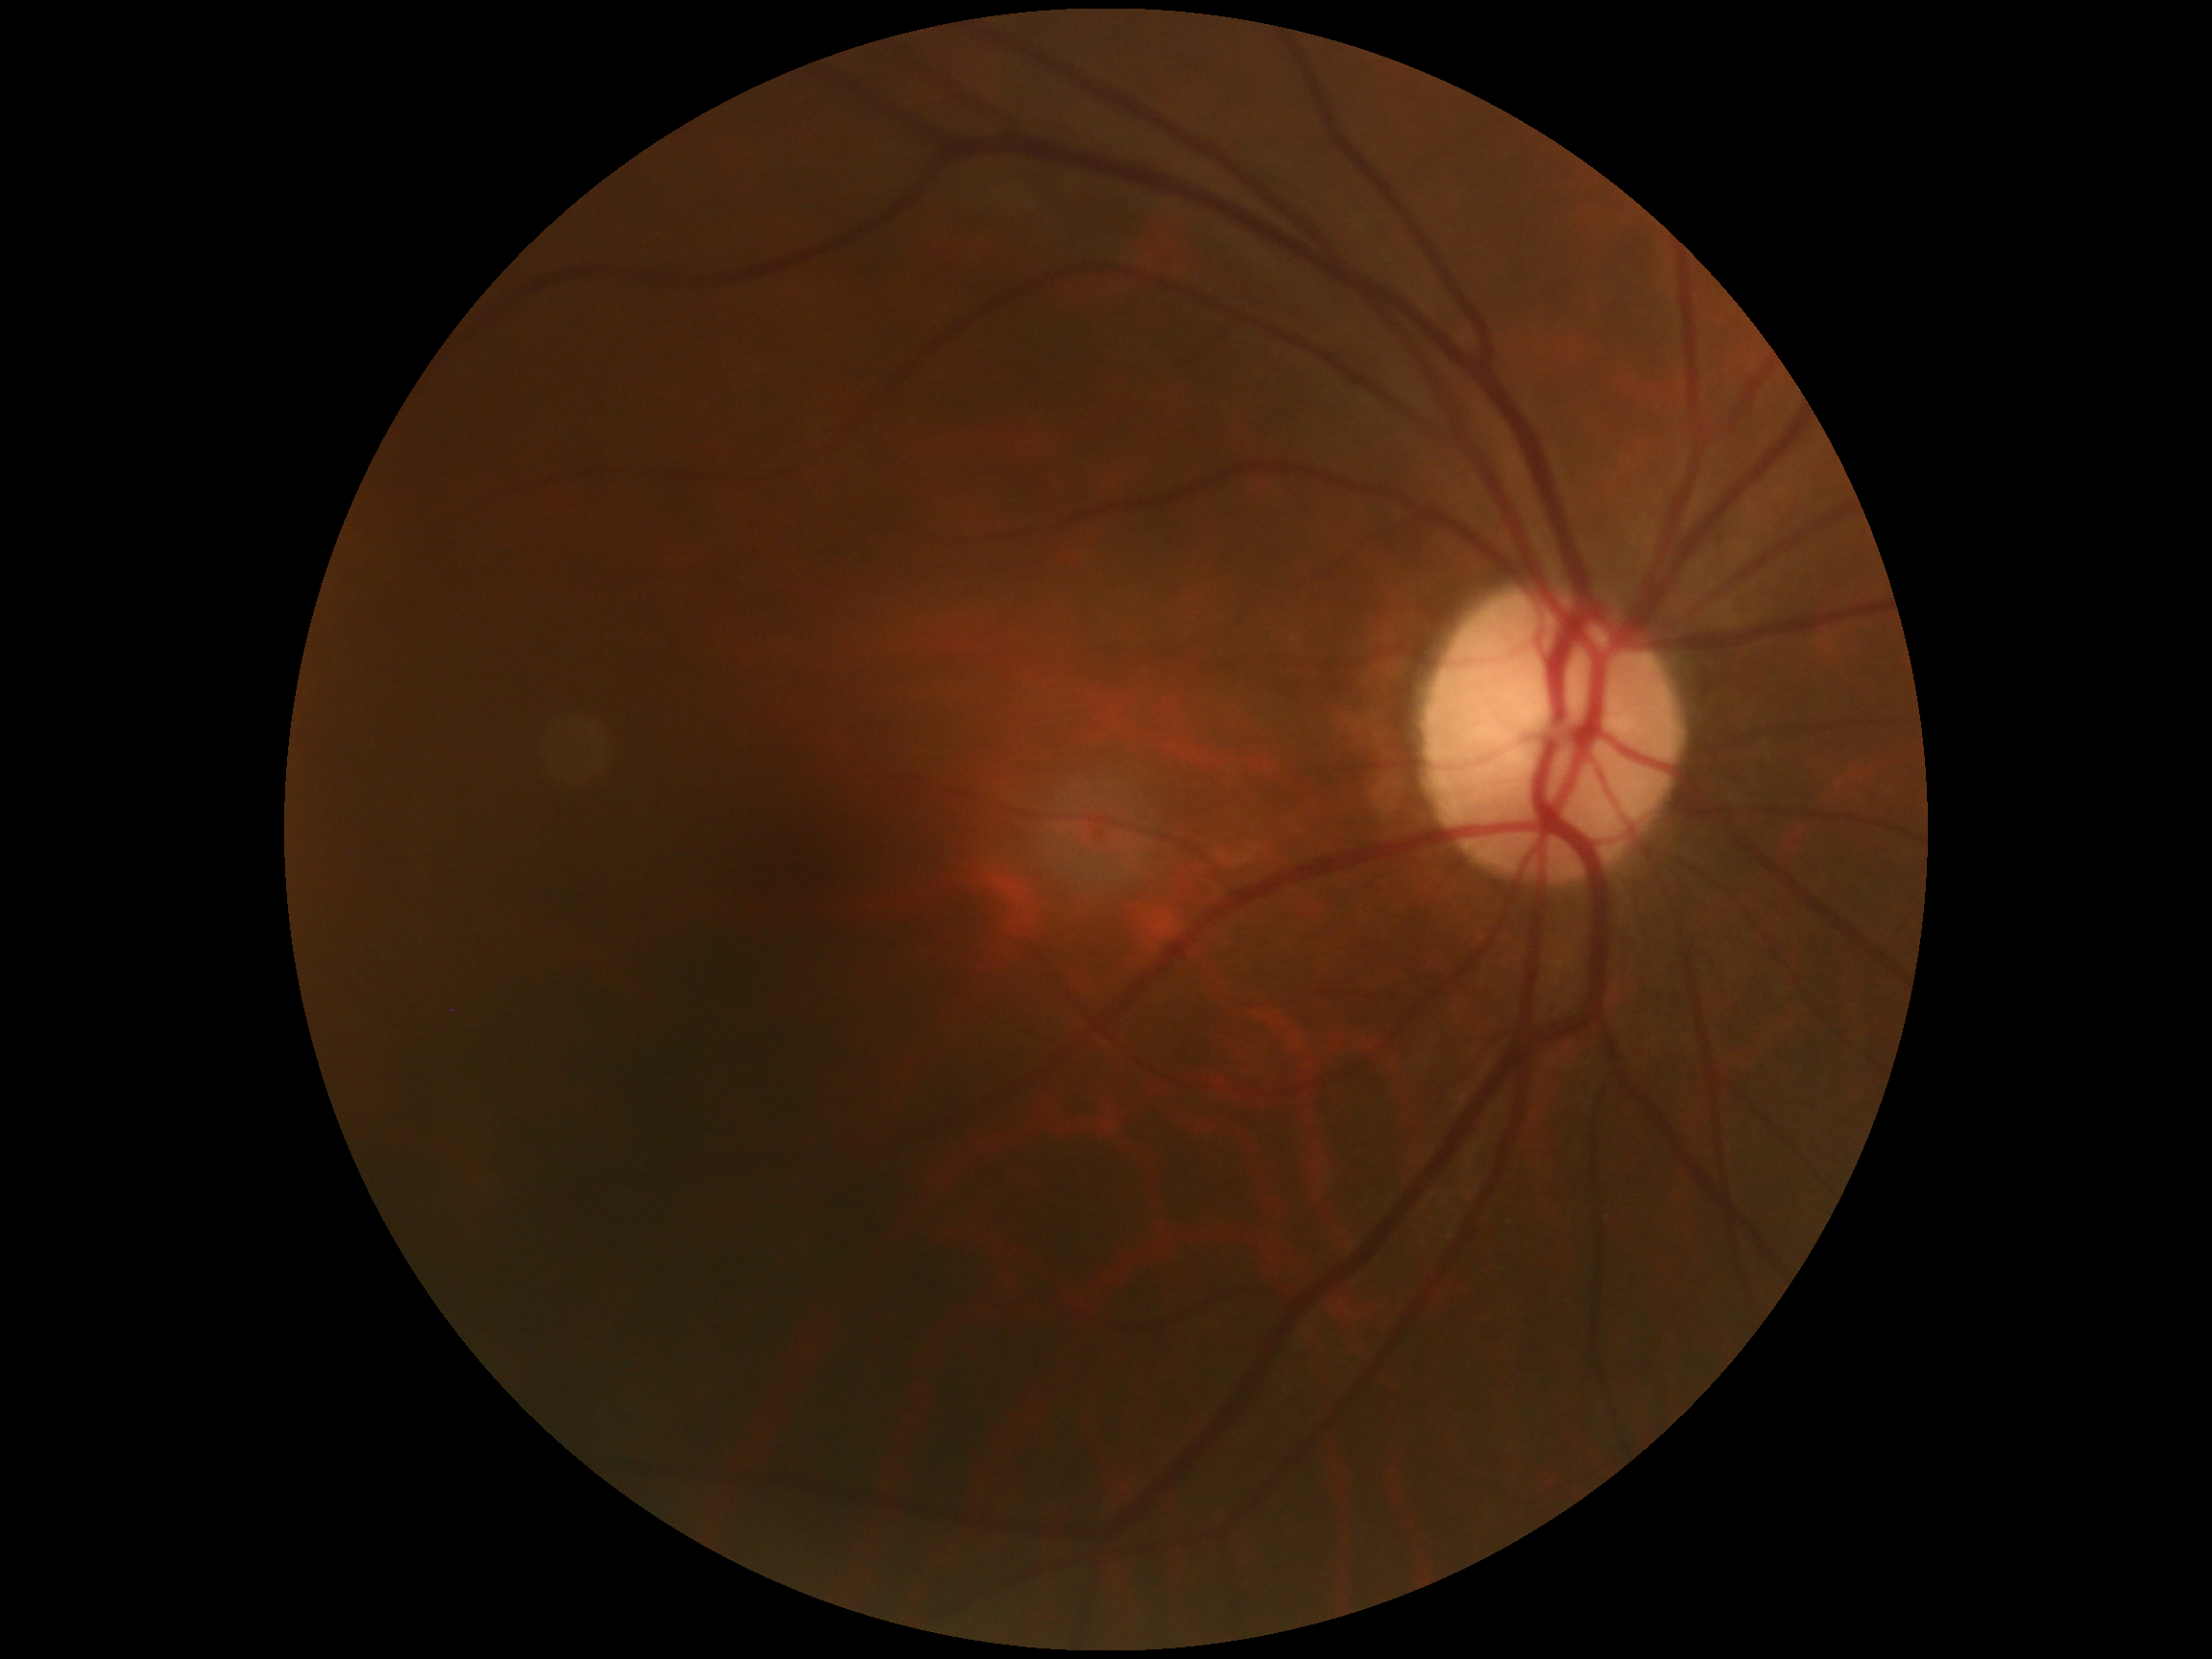

{
  "dr_grade": "grade 0"
}